Image size 2352x1568.
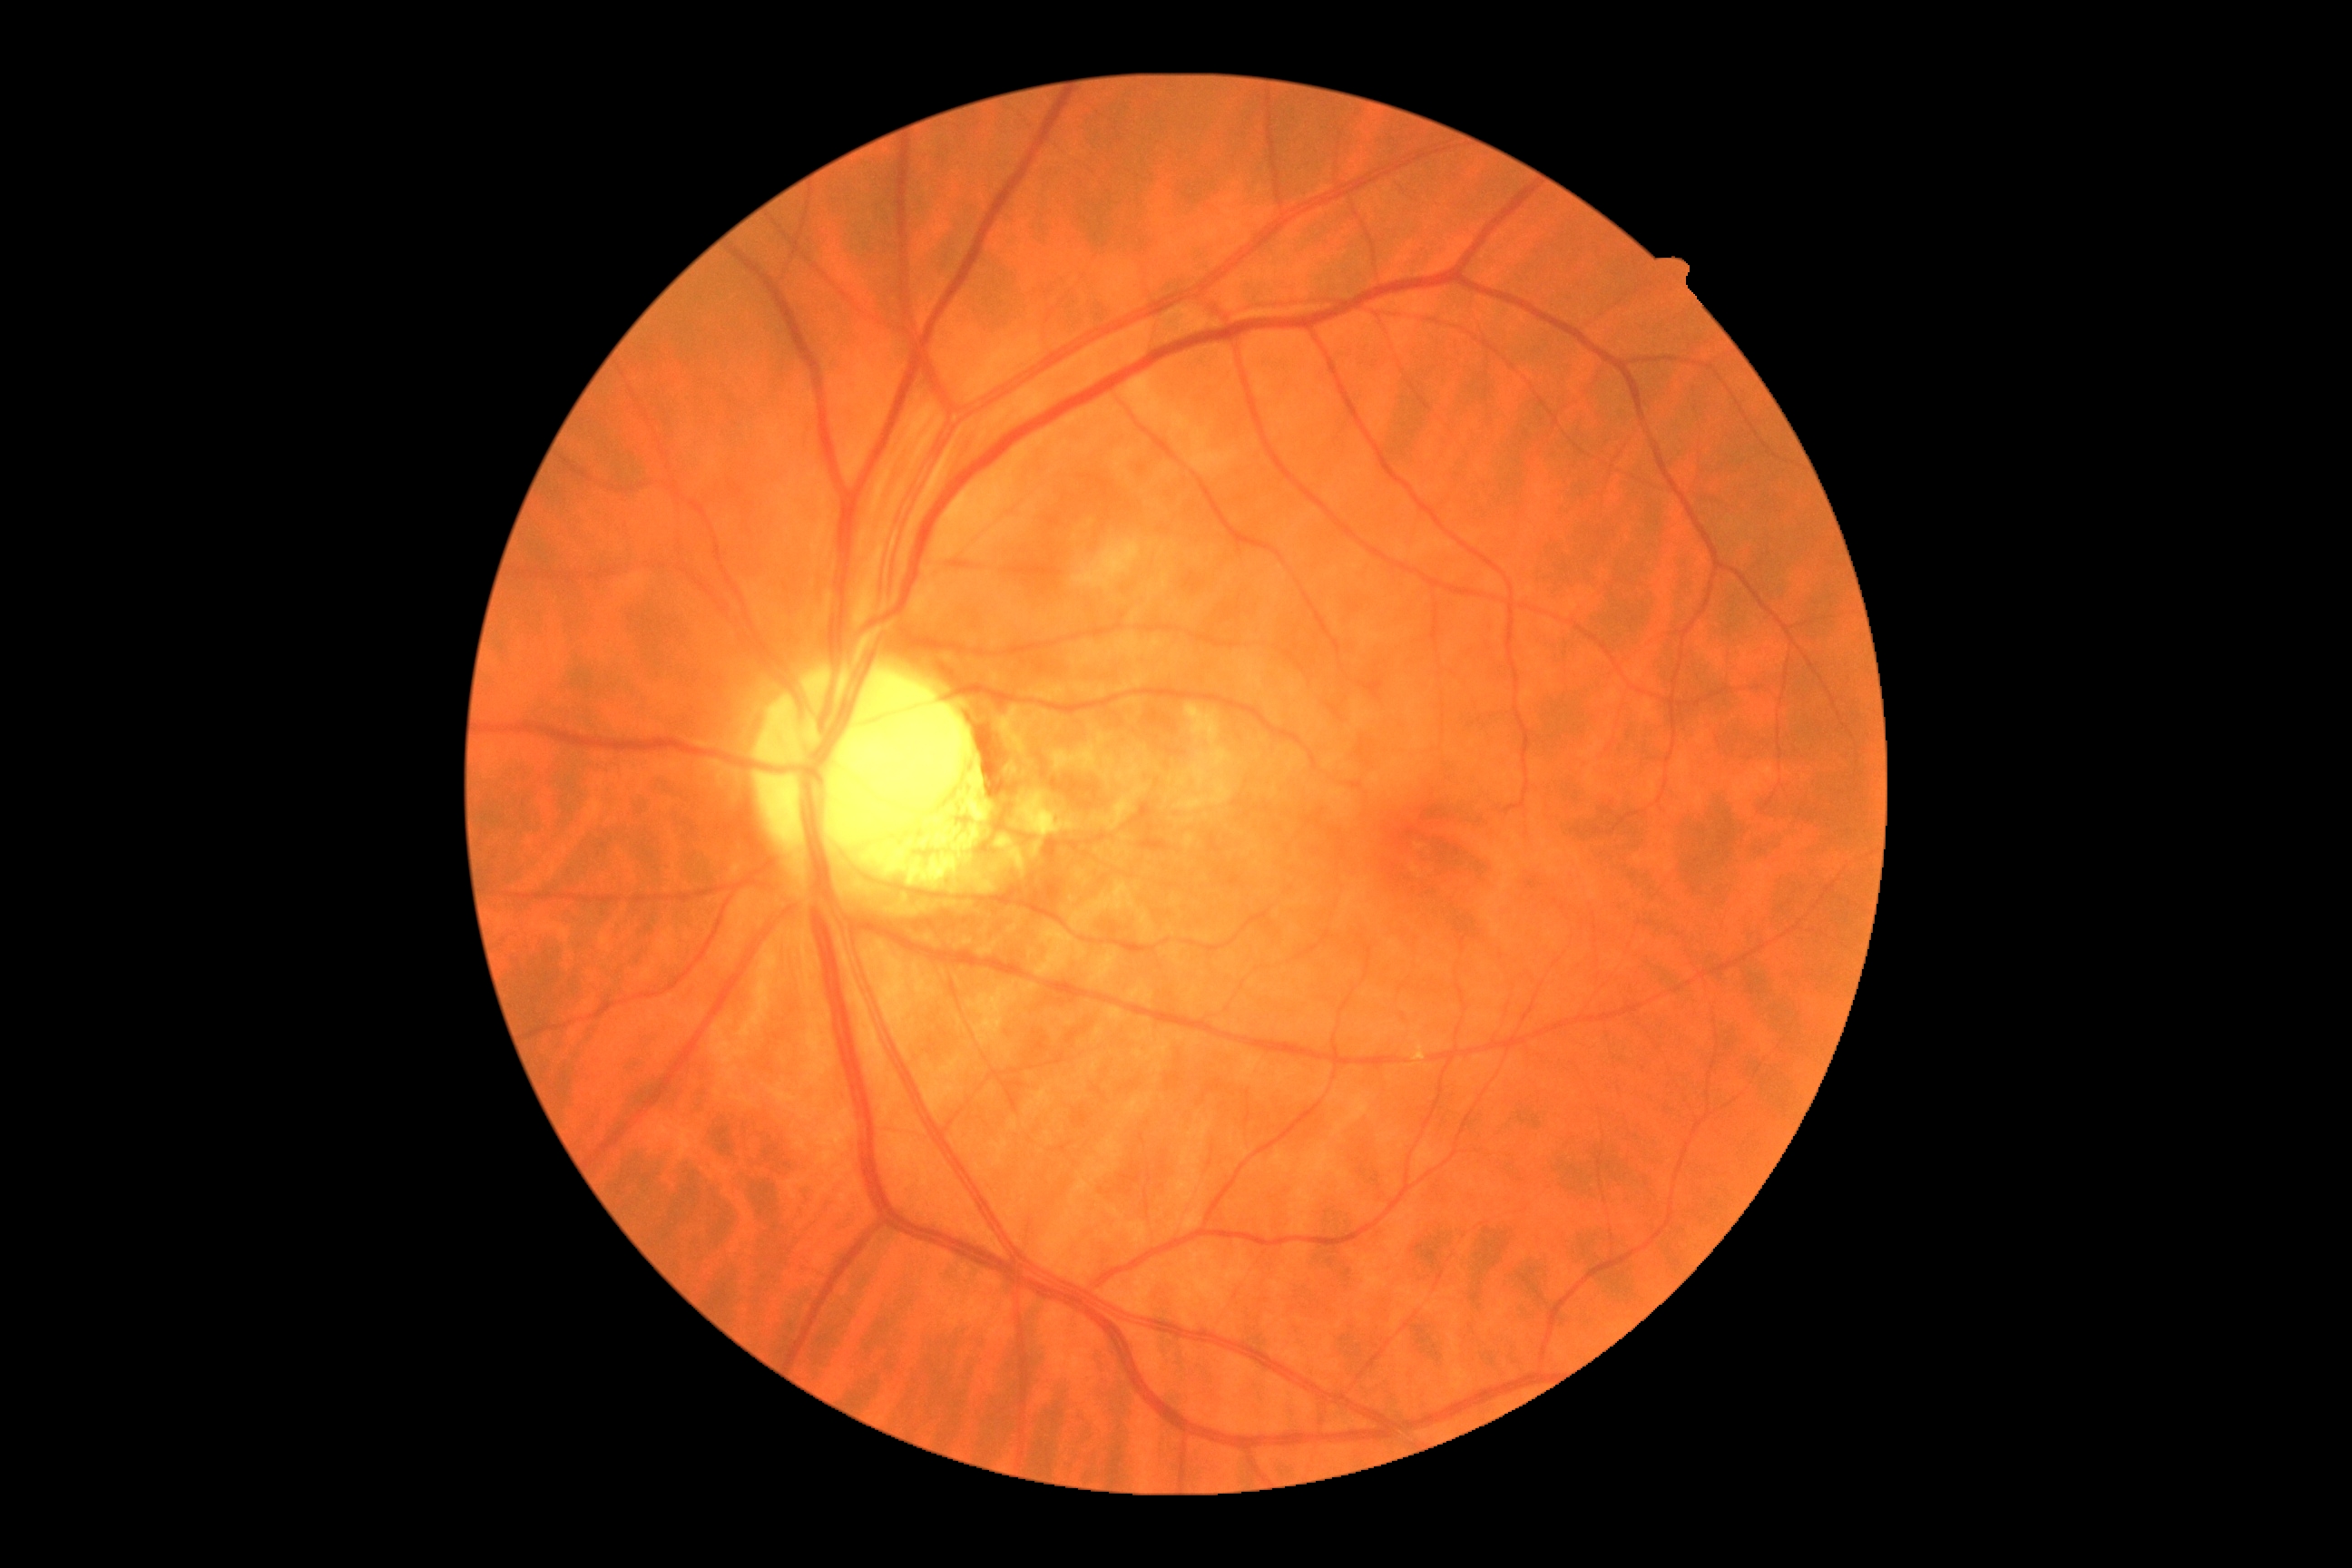

DR severity: no apparent diabetic retinopathy (grade 0).